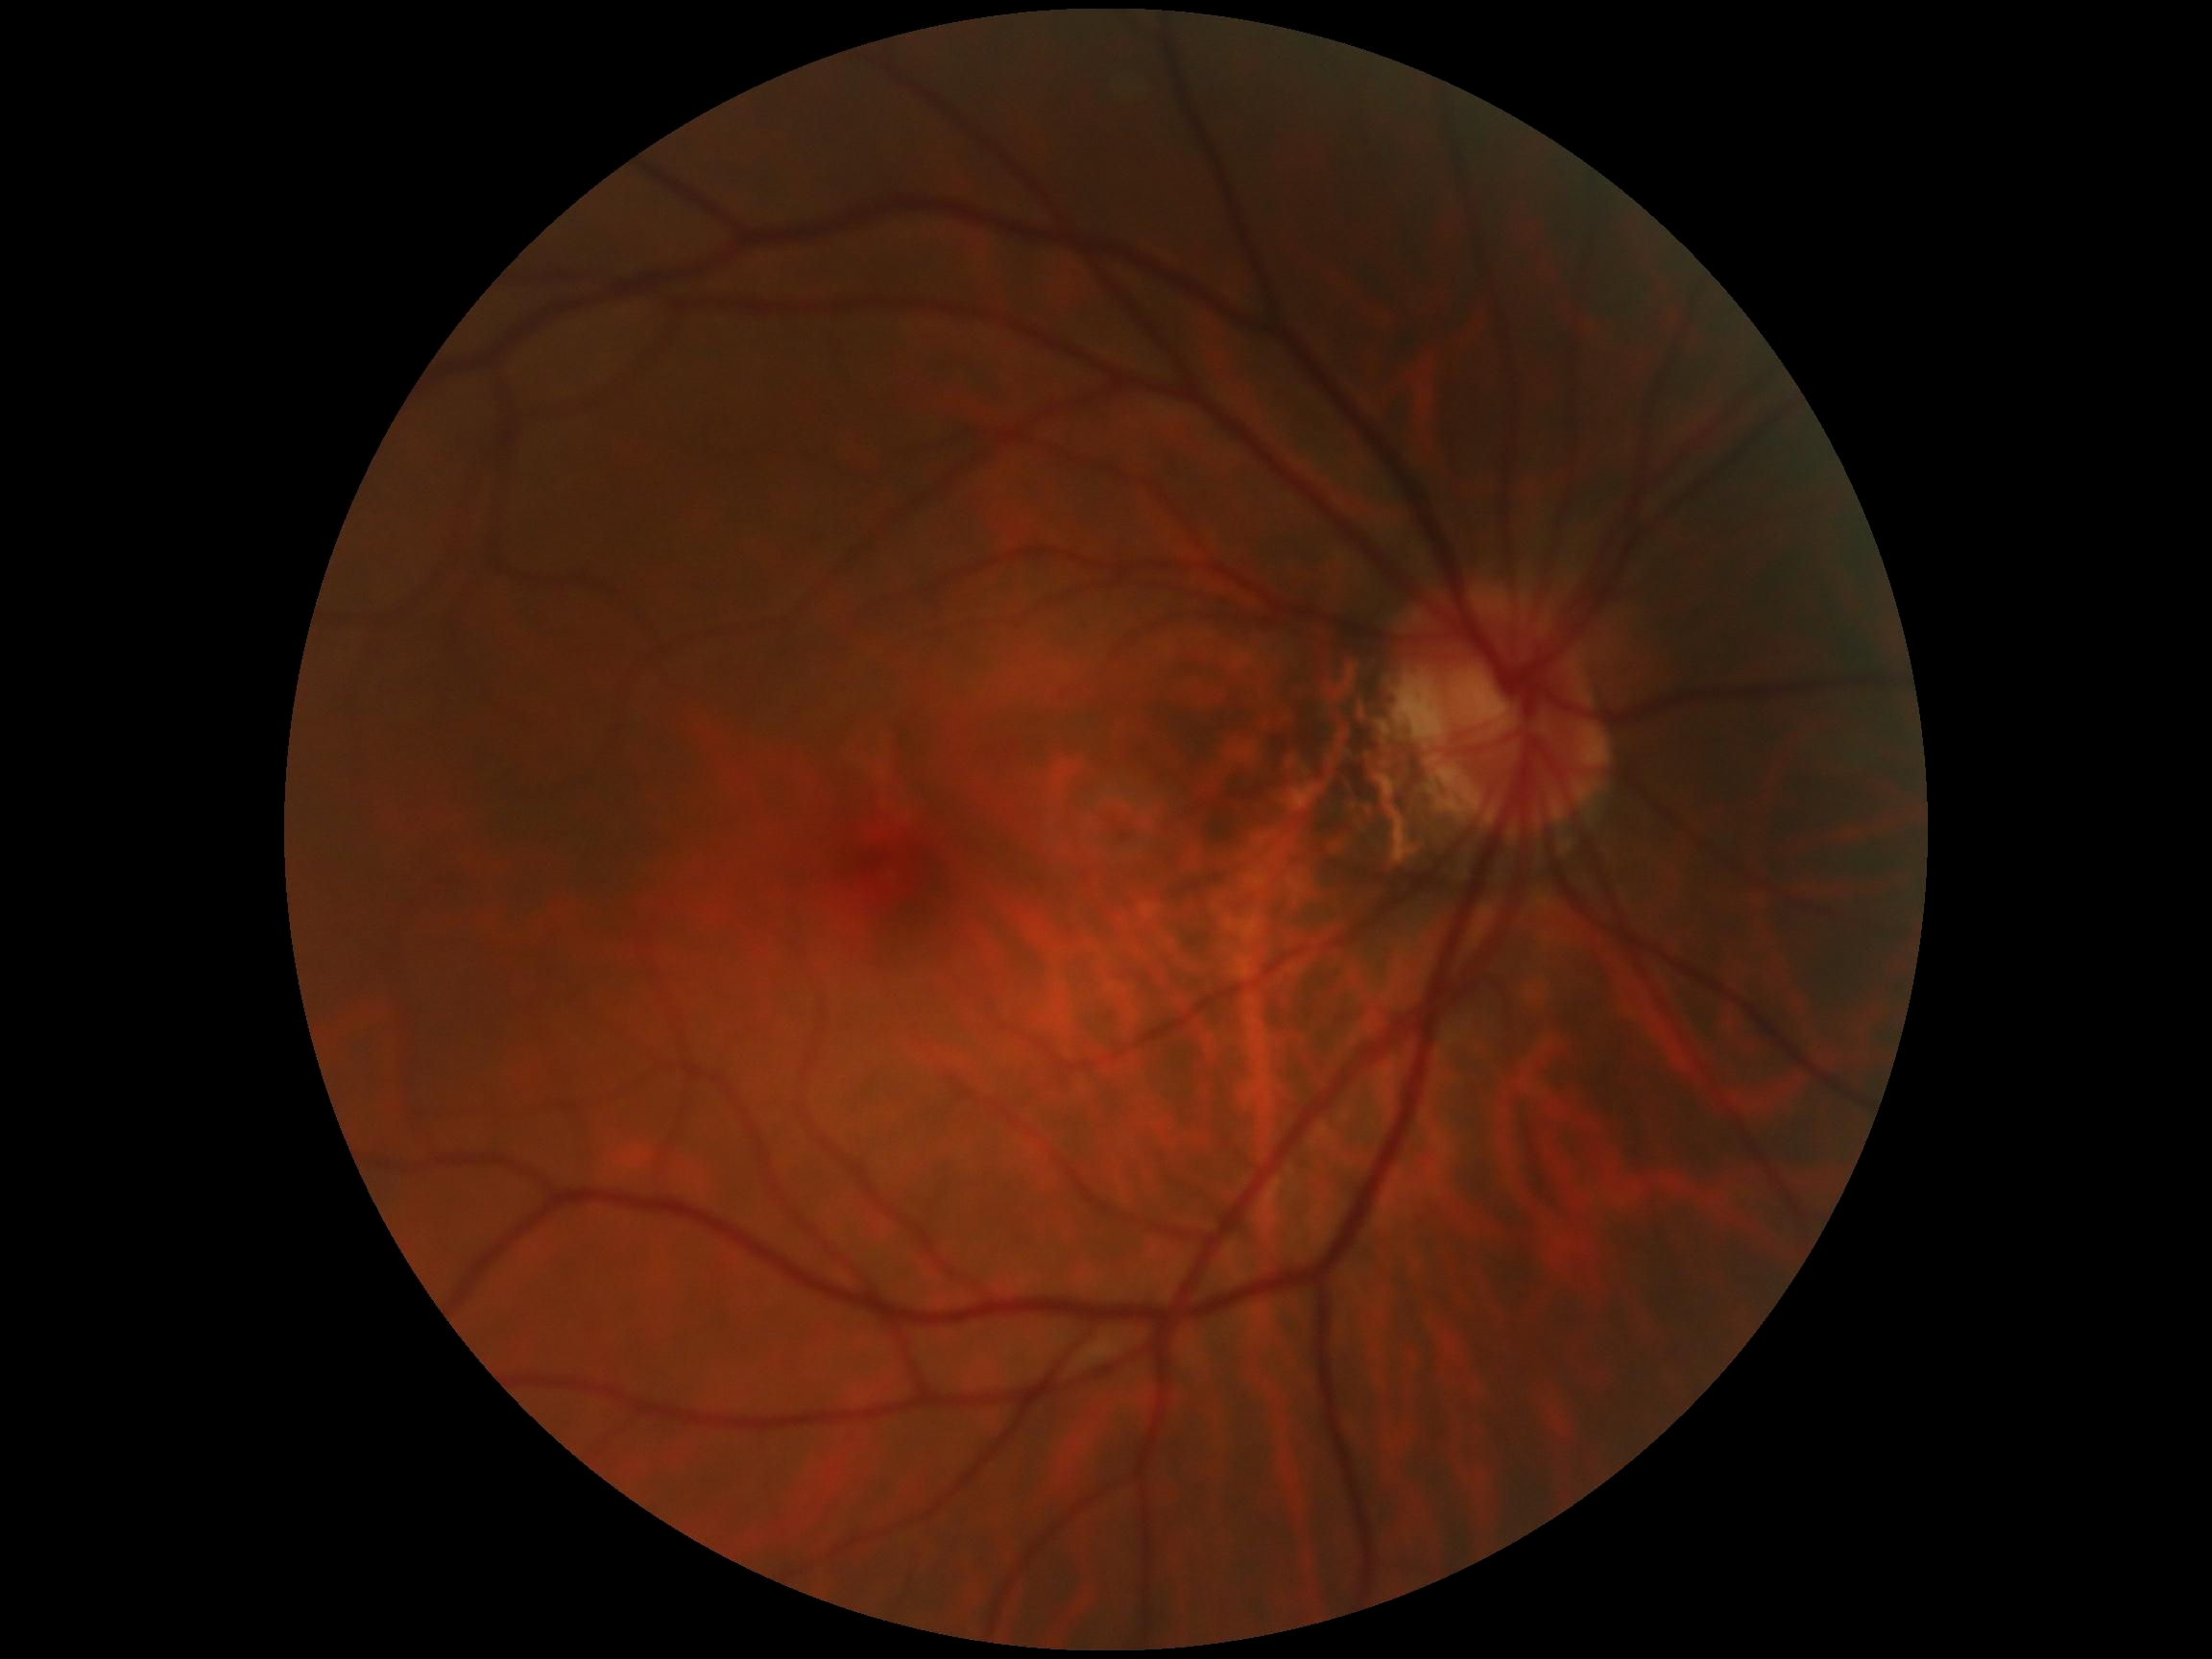
  dr_grade: 0 — no visible signs of diabetic retinopathy